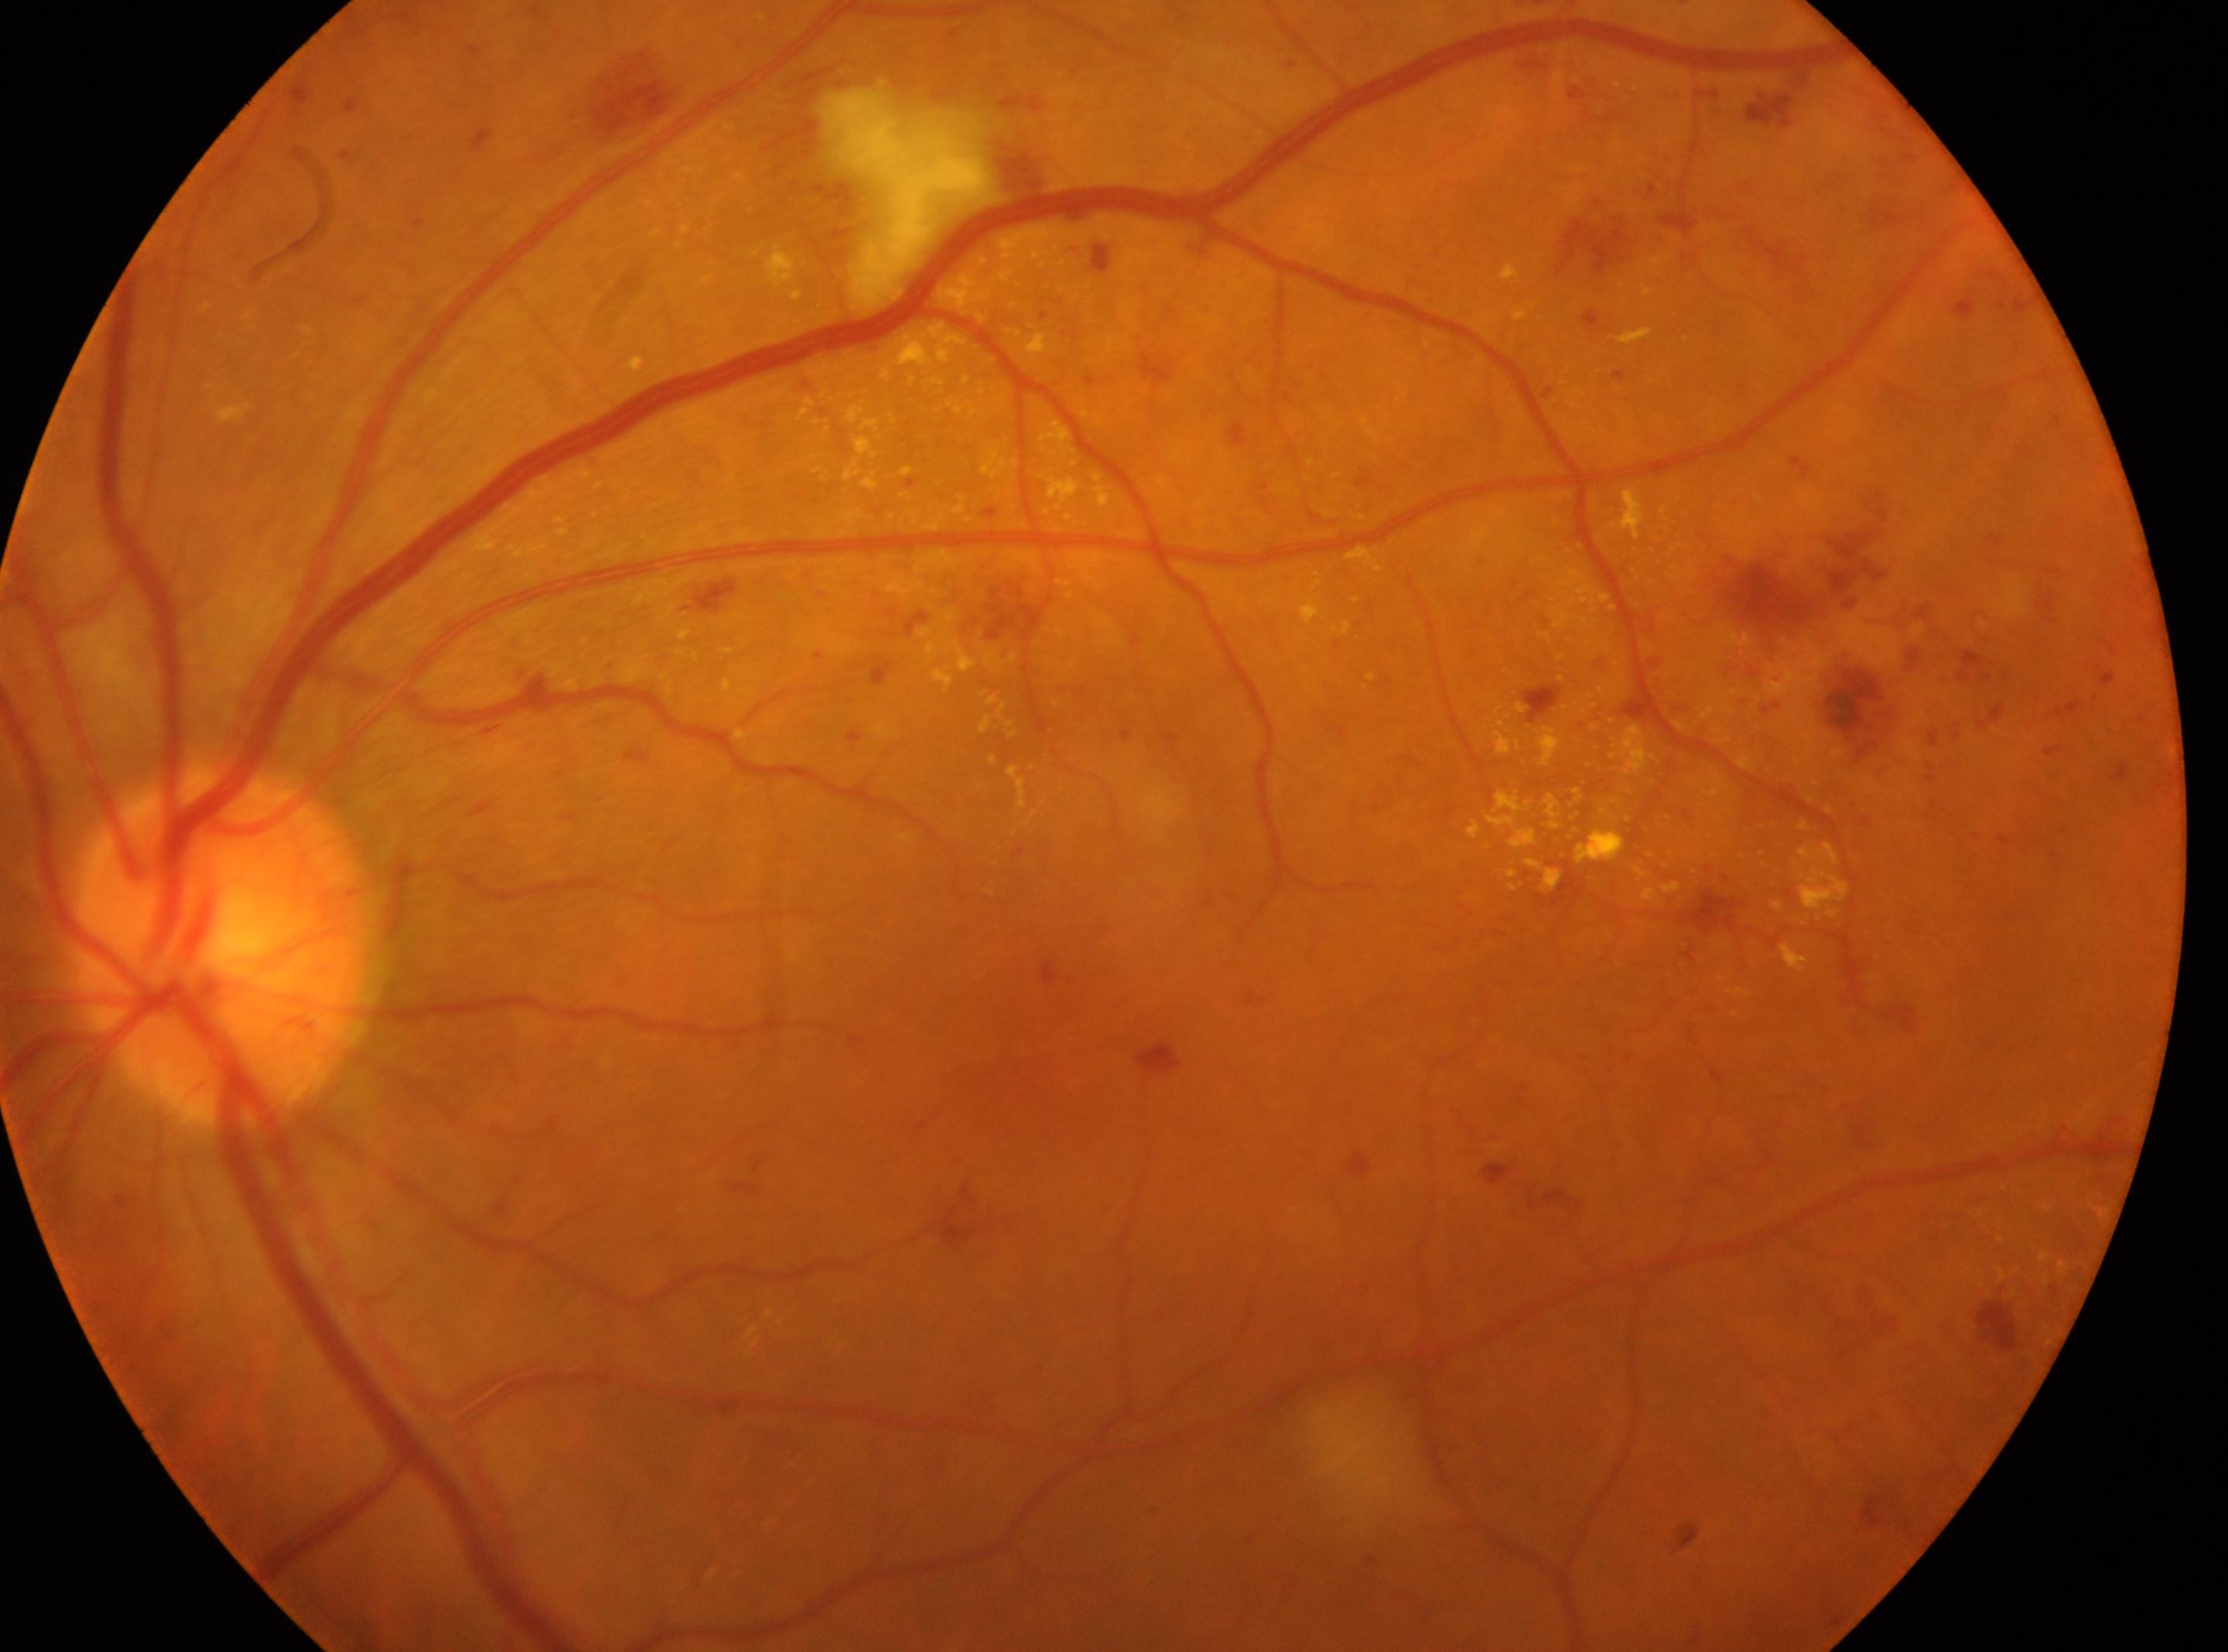

DR grade: 2 — more than just microaneurysms but less than severe NPDR.
Foveal center: (x=1030, y=1073).
Imaged eye: left.
Optic nerve head: (x=223, y=944).
DR class: non-proliferative diabetic retinopathy.